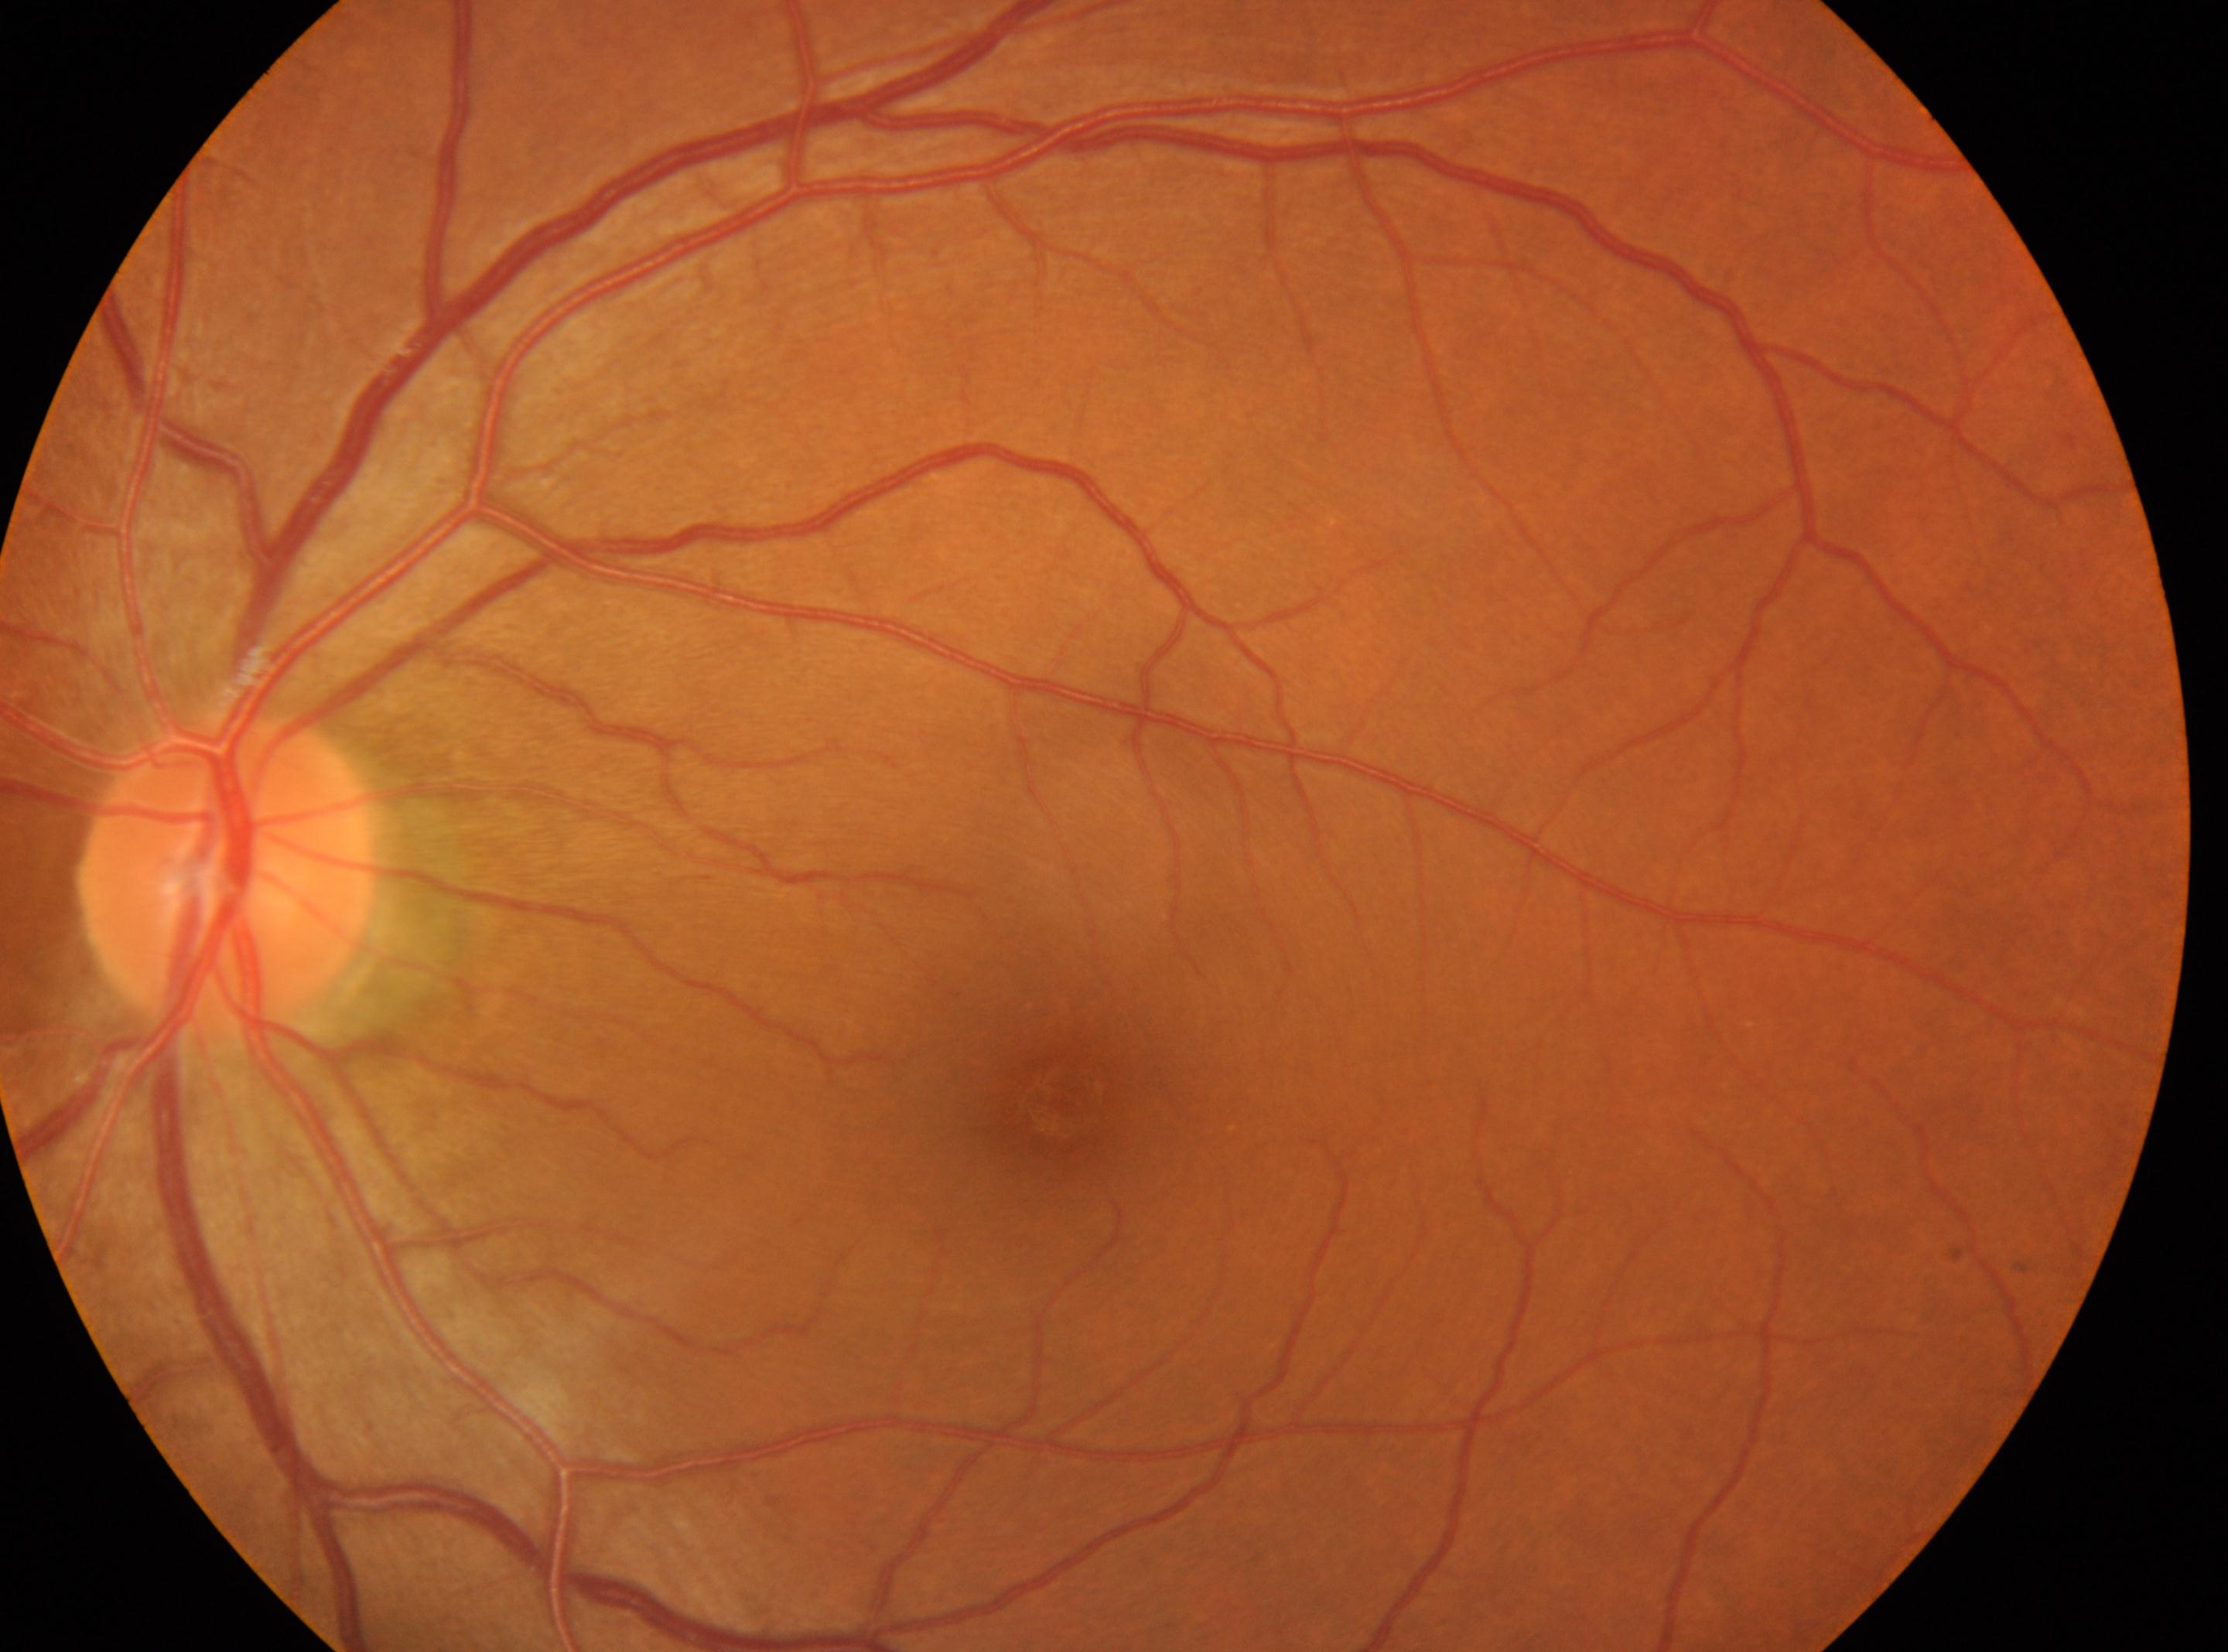
Imaged eye: the left eye.
The fovea center is at 1063, 1095.
The ONH is at 226, 872.
DR: no apparent retinopathy (grade 0).